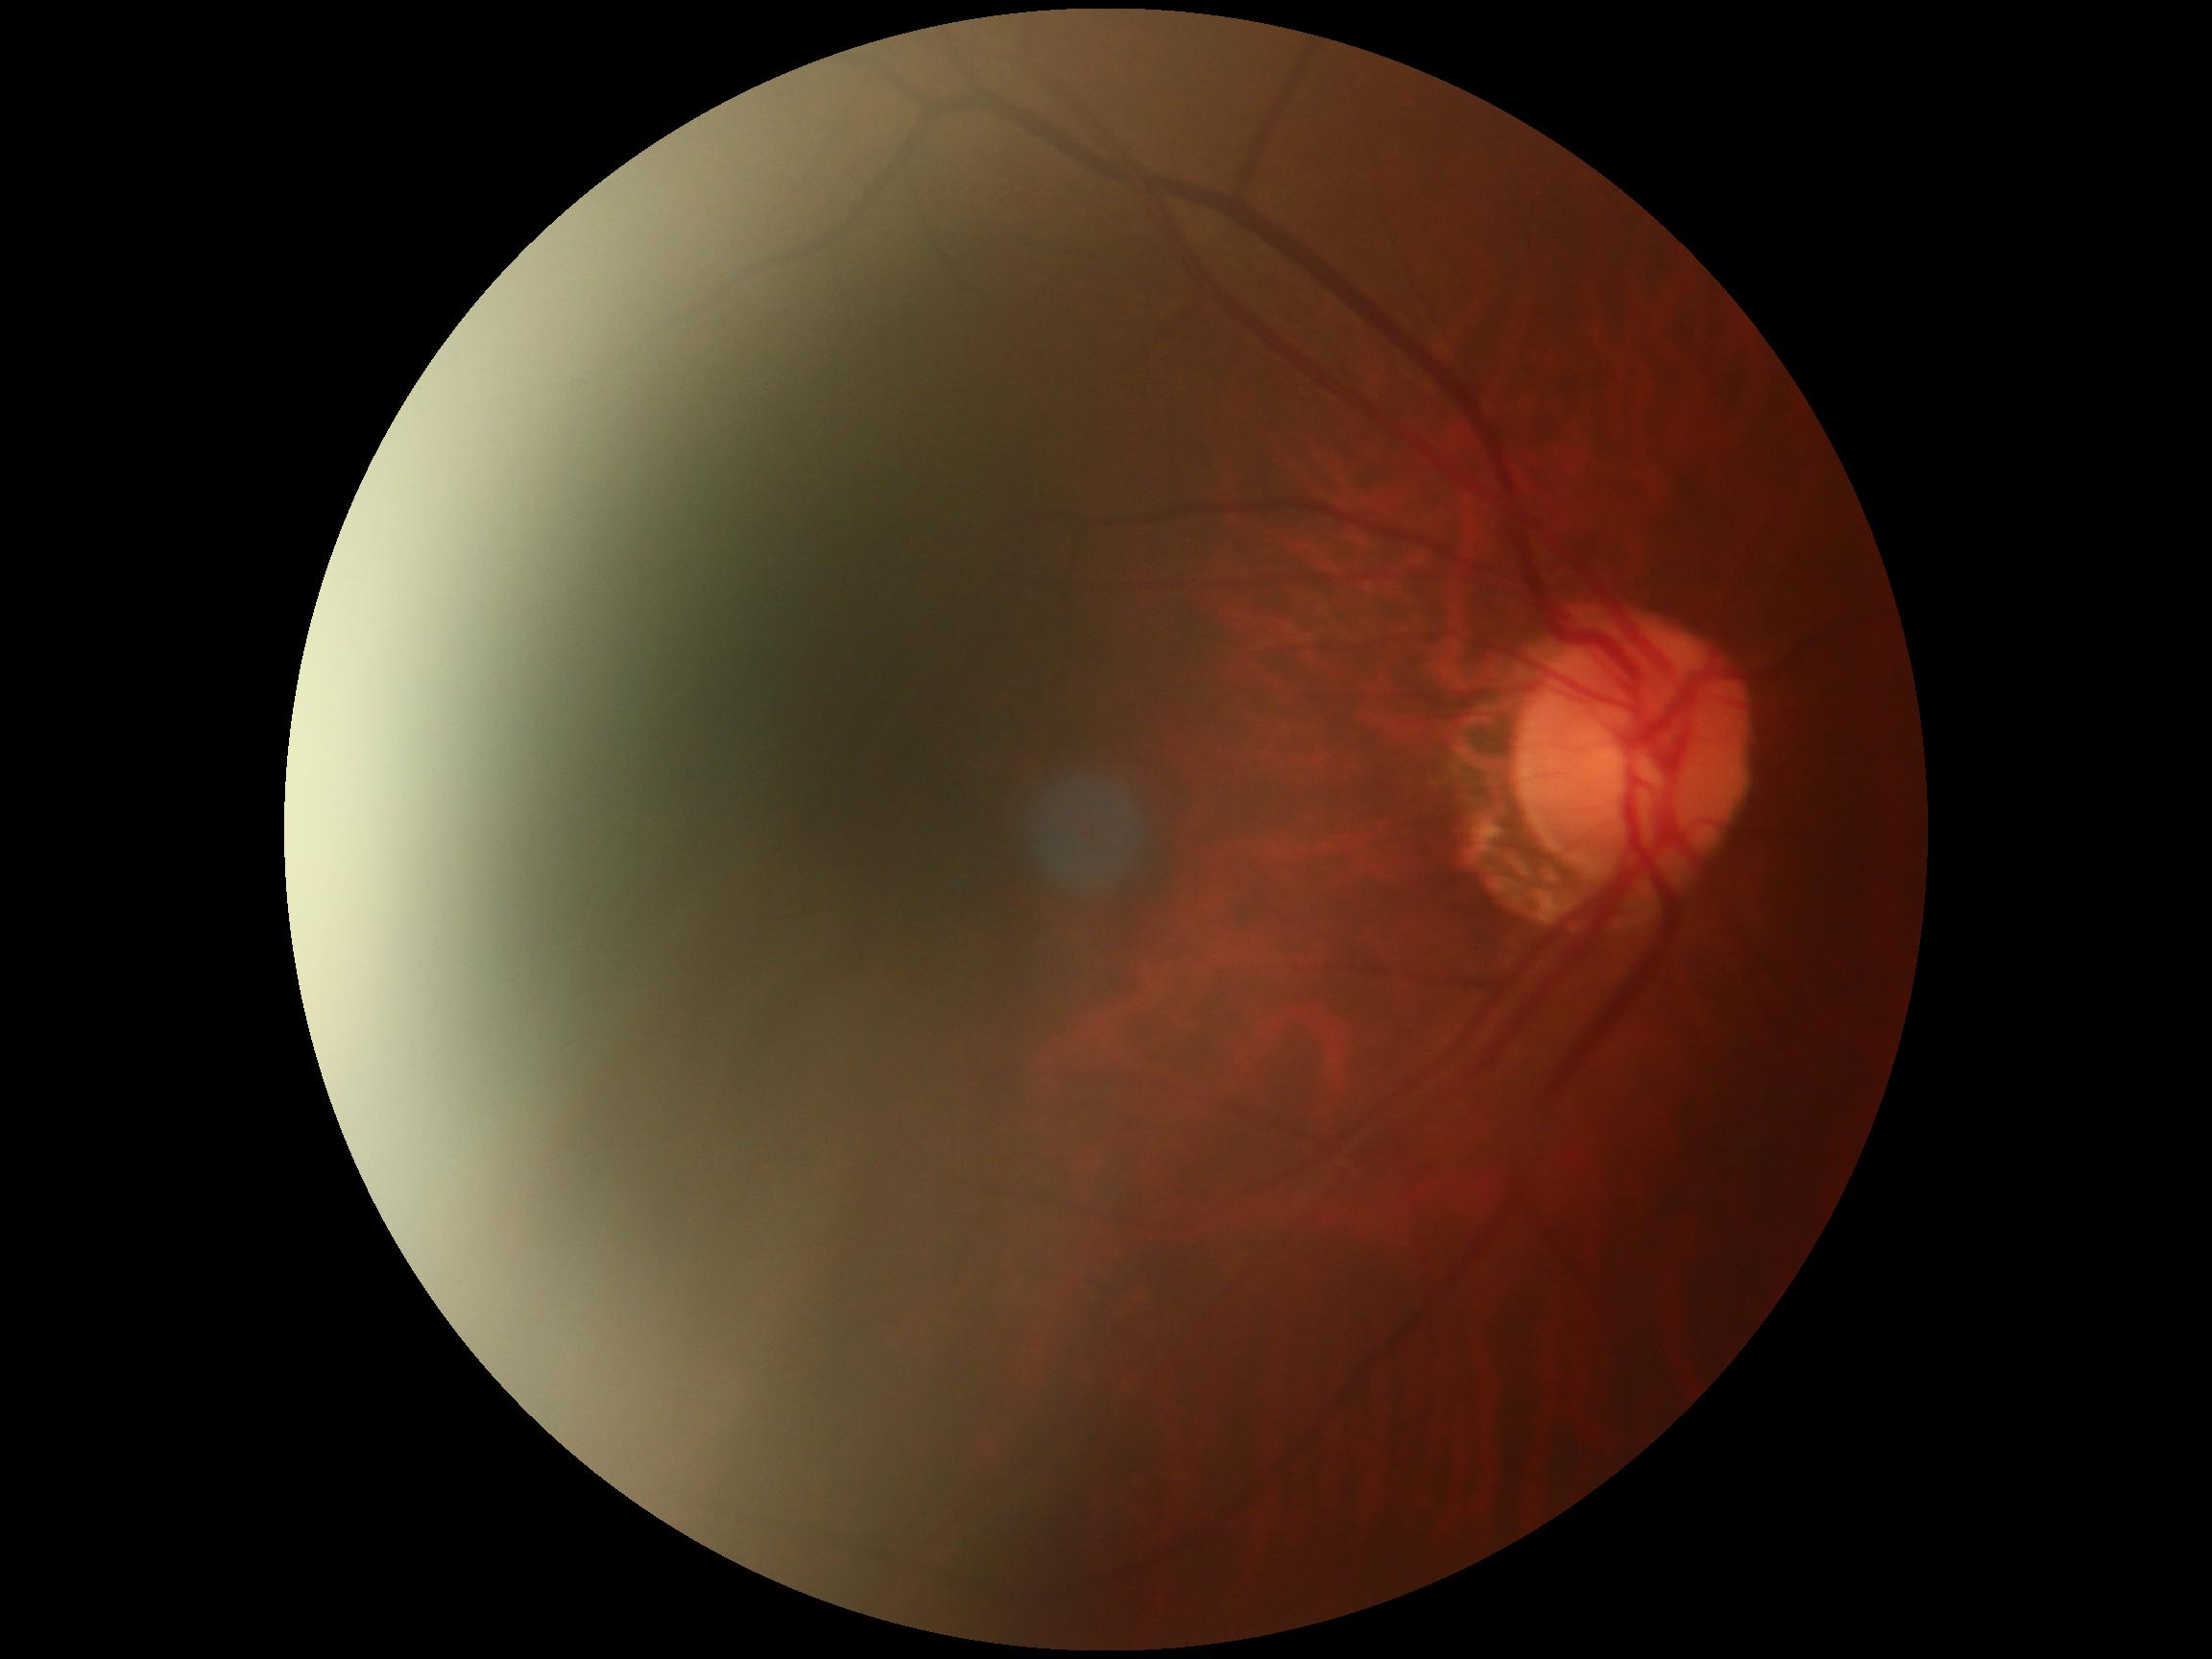 {
  "dr_impression": "no signs of DR",
  "dr_grade": "no apparent retinopathy (grade 0)"
}